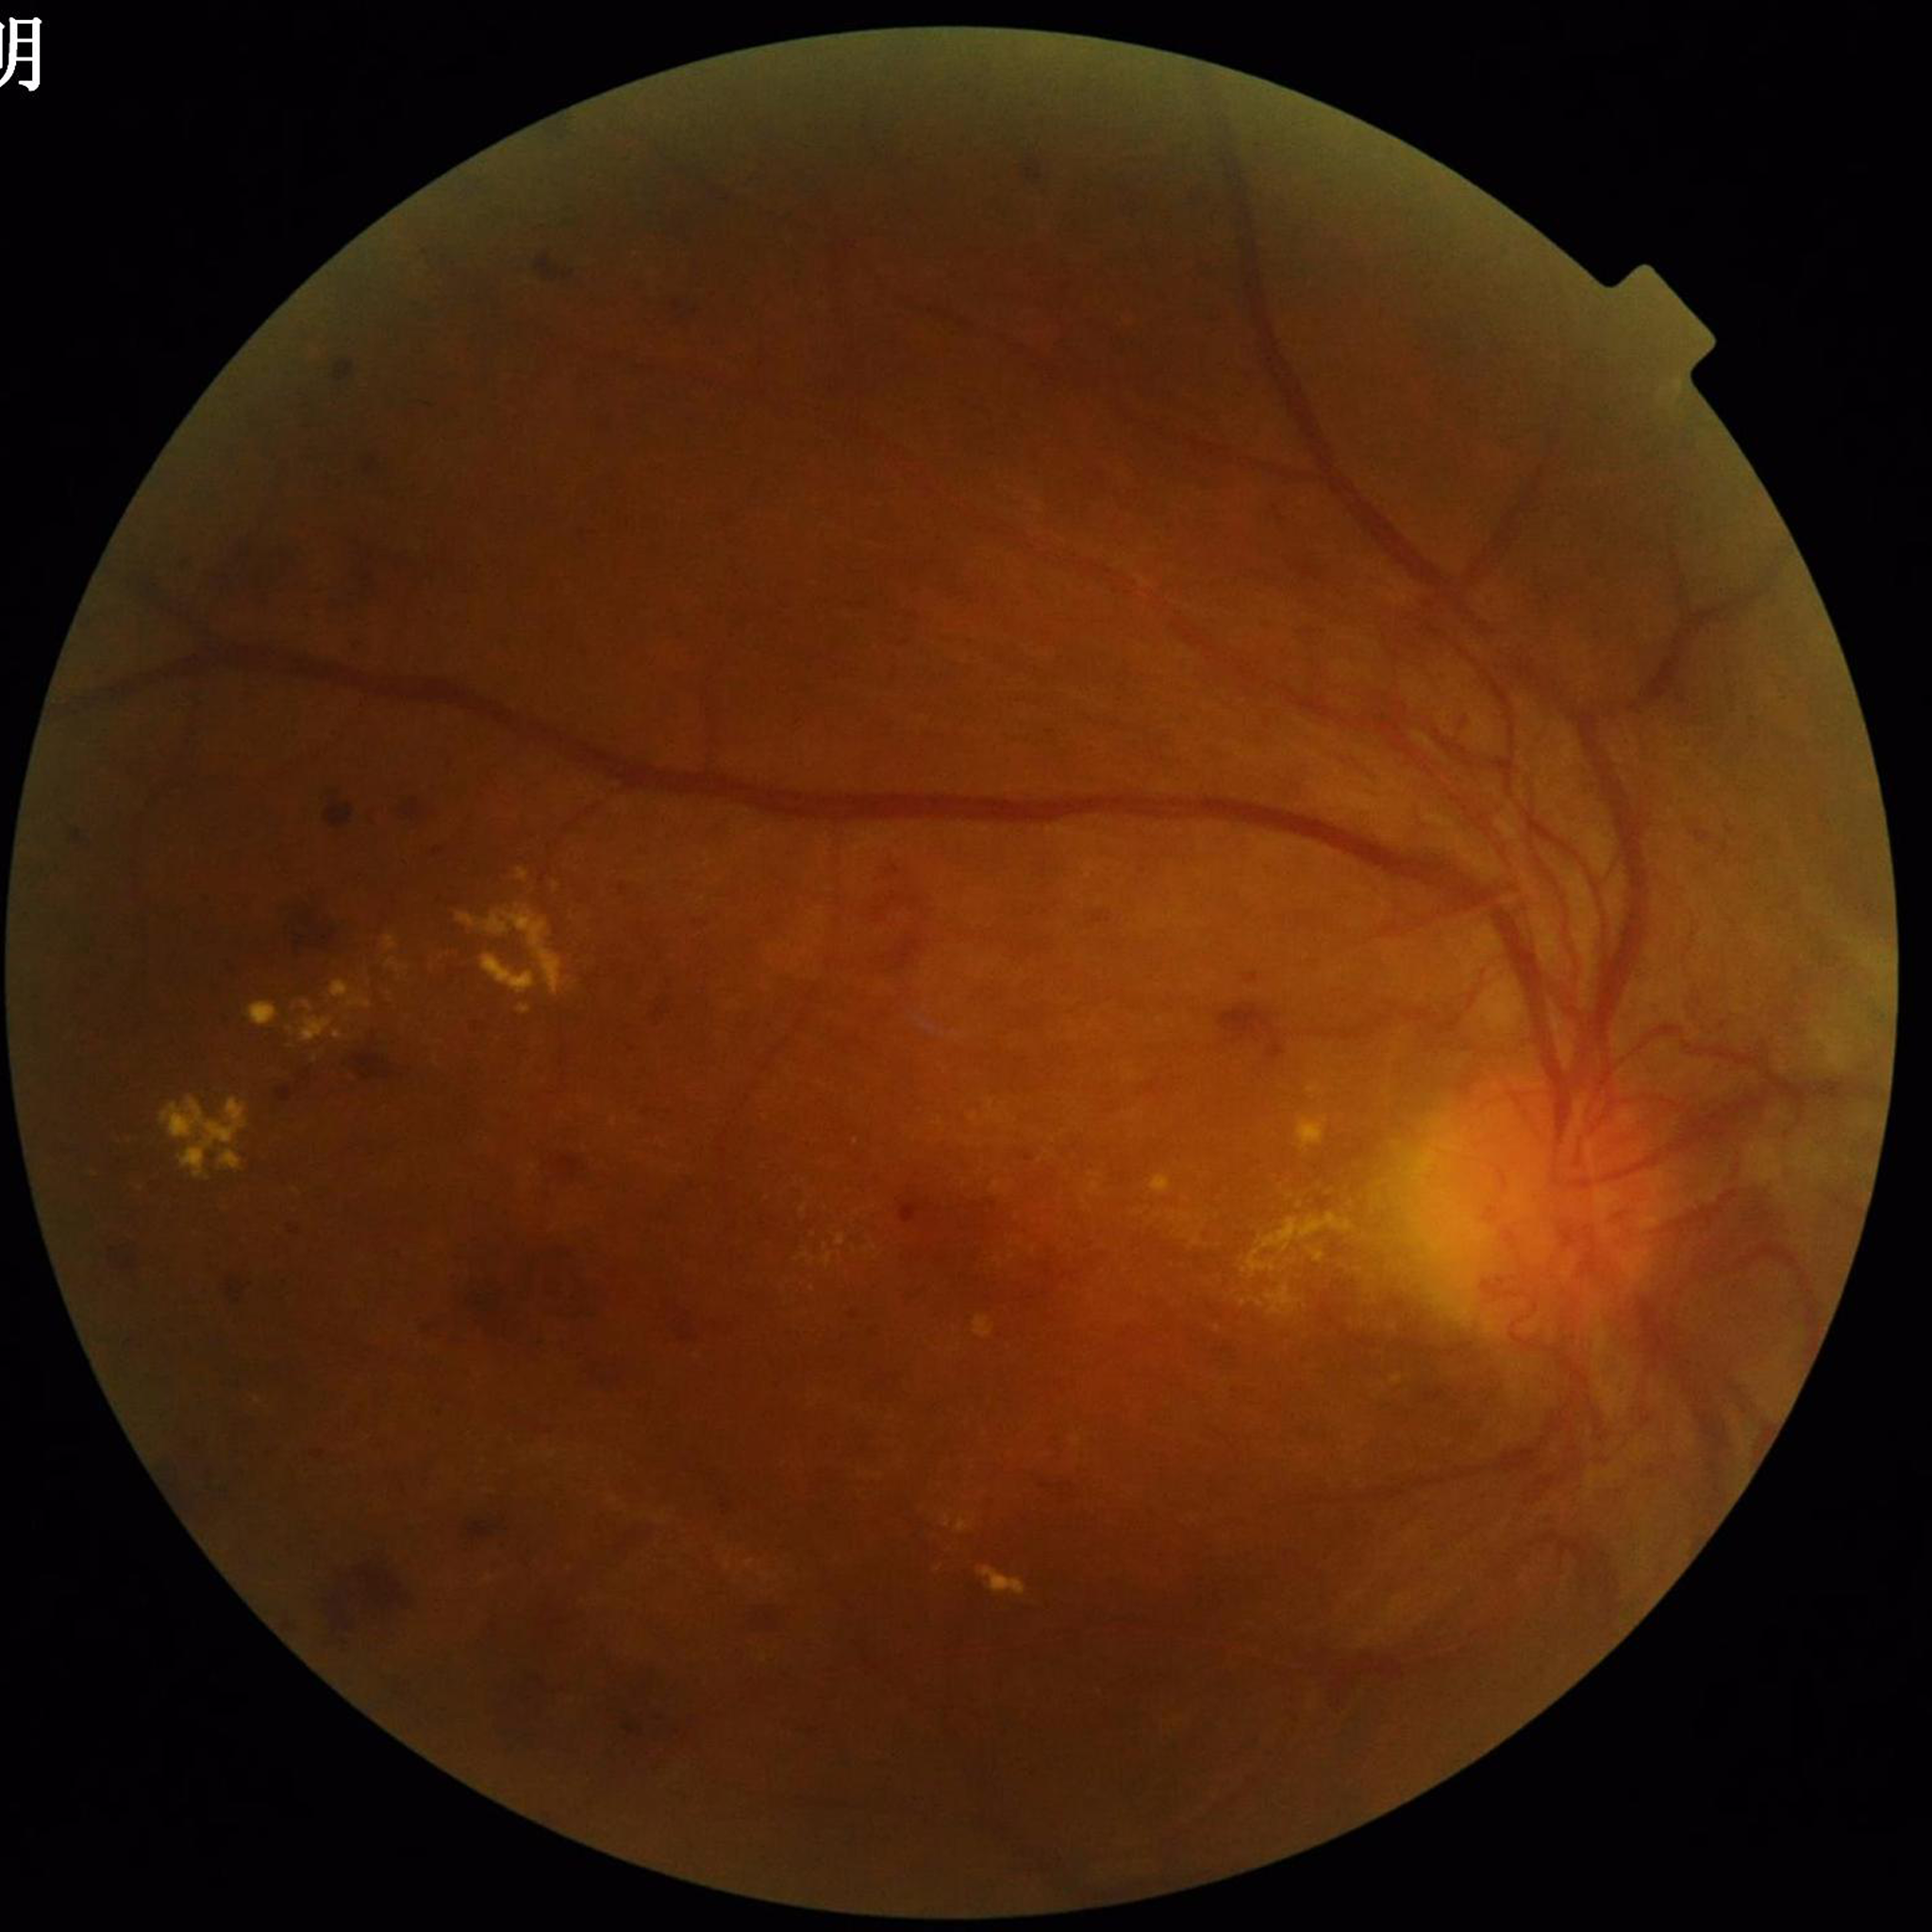 Quality: no concerns identified. This fundus photograph is from a patient diagnosed with diabetic retinopathy (DR).